Captured with the Clarity RetCam 3 (130° field of view). 640x480. Wide-field contact fundus photograph of an infant:
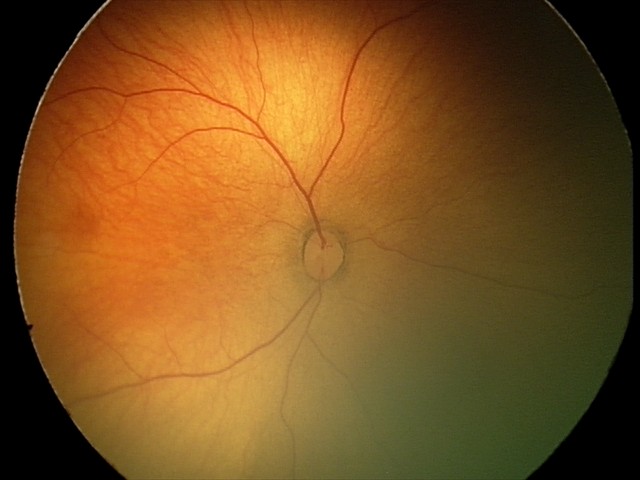
Physiological retinal appearance for postconceptual age.